Color fundus photograph: 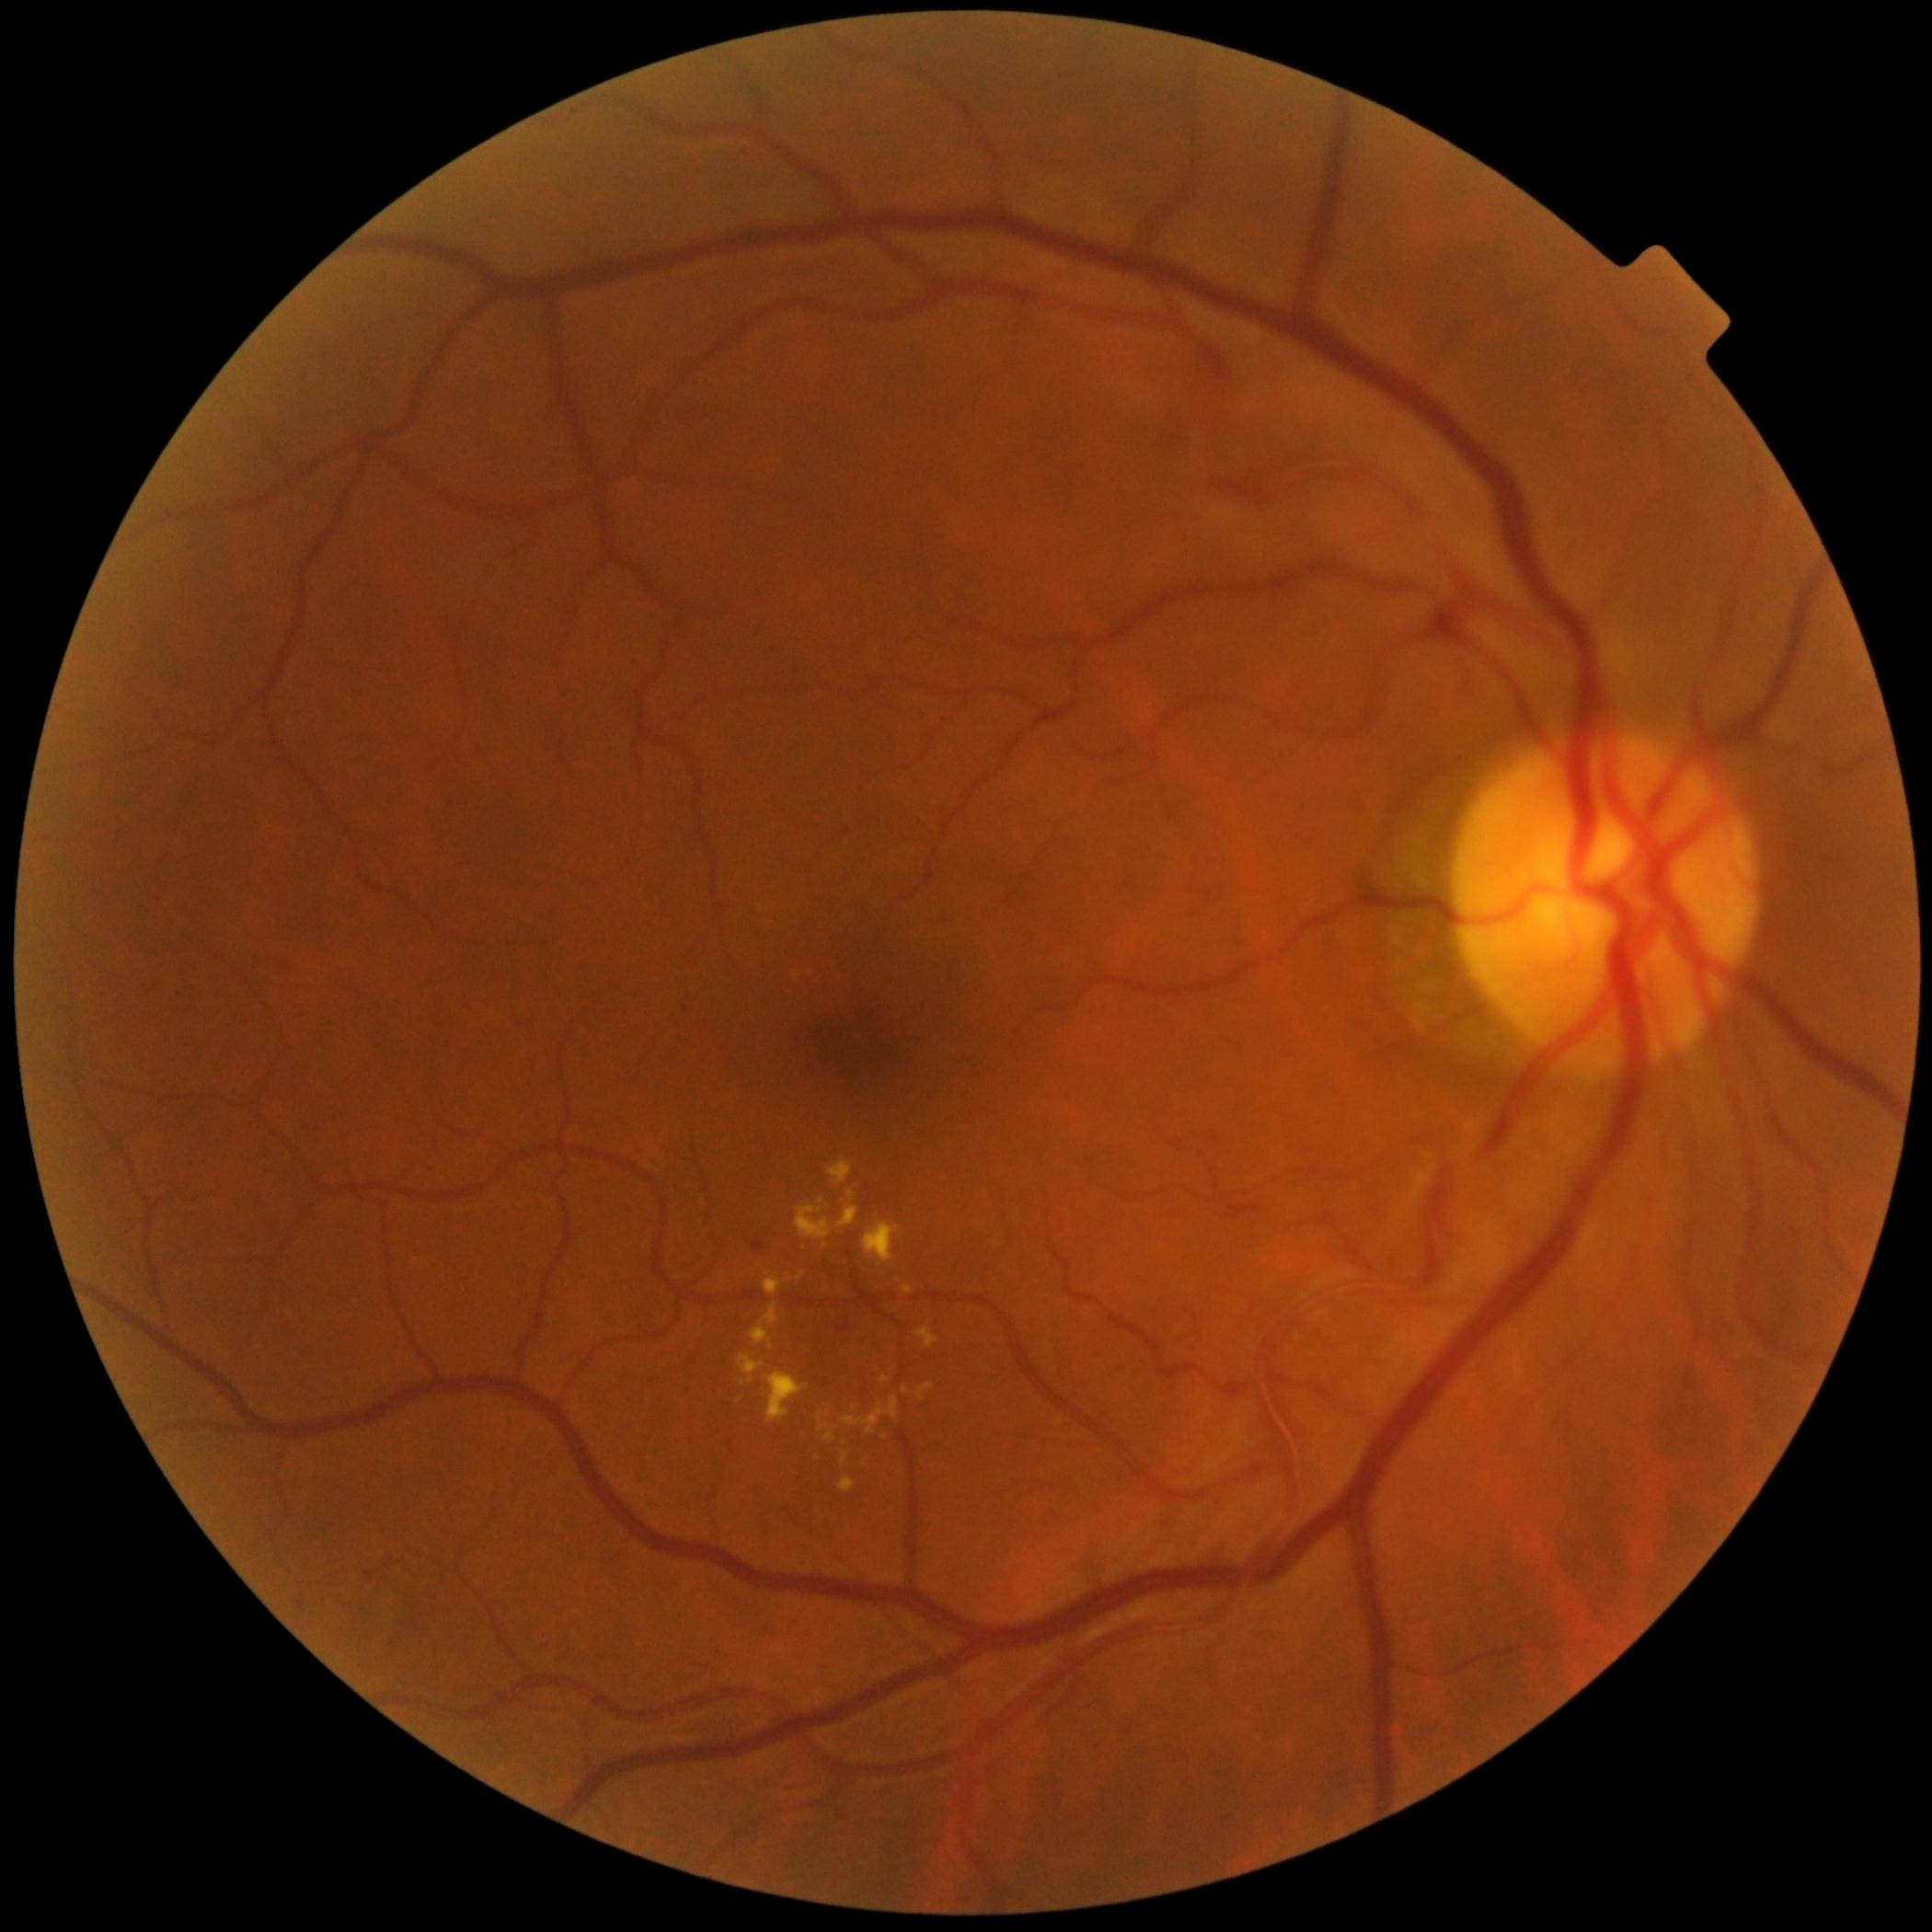 Diabetic retinopathy (DR): grade 2; non-proliferative diabetic retinopathy
Representative lesions:
soft exudates (SEs): none
microaneurysms (MAs): BBox(753, 1239, 765, 1252)
MAs (small, approximate centers) near (x=686, y=1008) | (x=369, y=1573)
hemorrhages (HEs): none
hard exudates (EXs) (continued): BBox(862, 1223, 902, 1261) | BBox(905, 1286, 914, 1294) | BBox(819, 1414, 831, 1432) | BBox(918, 1381, 935, 1401) | BBox(795, 1204, 833, 1239) | BBox(765, 1372, 810, 1424) | BBox(799, 1273, 804, 1281) | BBox(838, 1206, 860, 1228) | BBox(829, 1159, 853, 1185) | BBox(842, 1450, 849, 1463)
EXs (small, approximate centers) near (x=822, y=1202) | (x=790, y=1278)